Non-mydriatic fundus camera, image size 240x240:
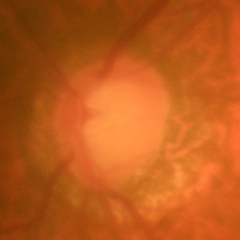

Optic disc appearance consistent with early glaucoma.